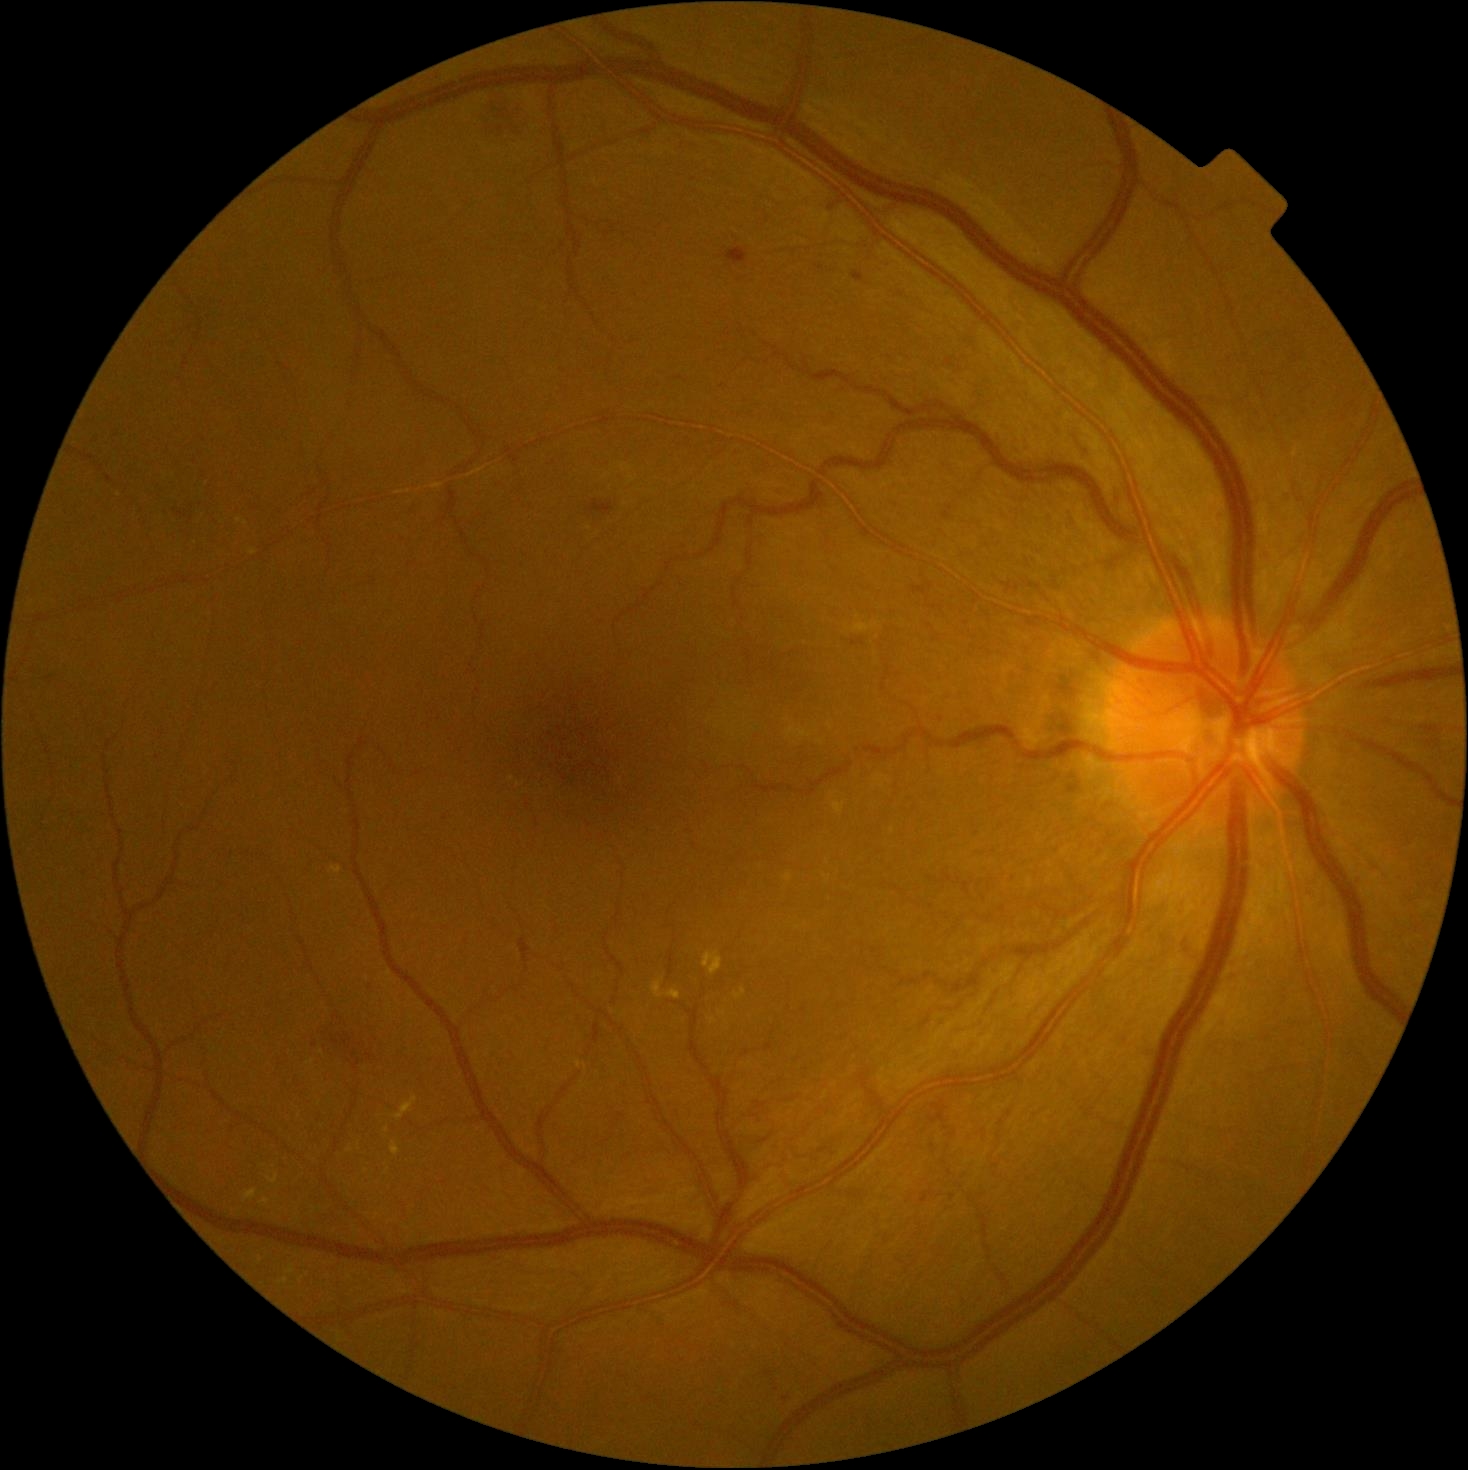   dr_grade: grade 2